Infant wide-field fundus photograph · 640 by 480 pixels:
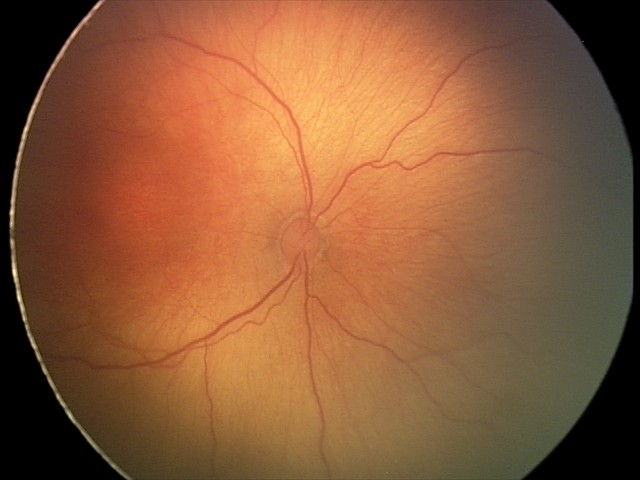

Impression = ROP stage 2 | plus form = absent.